Image size 2228x1652; central posterior field; retinal fundus photograph; captured after pupil dilation; 50-degree field of view — 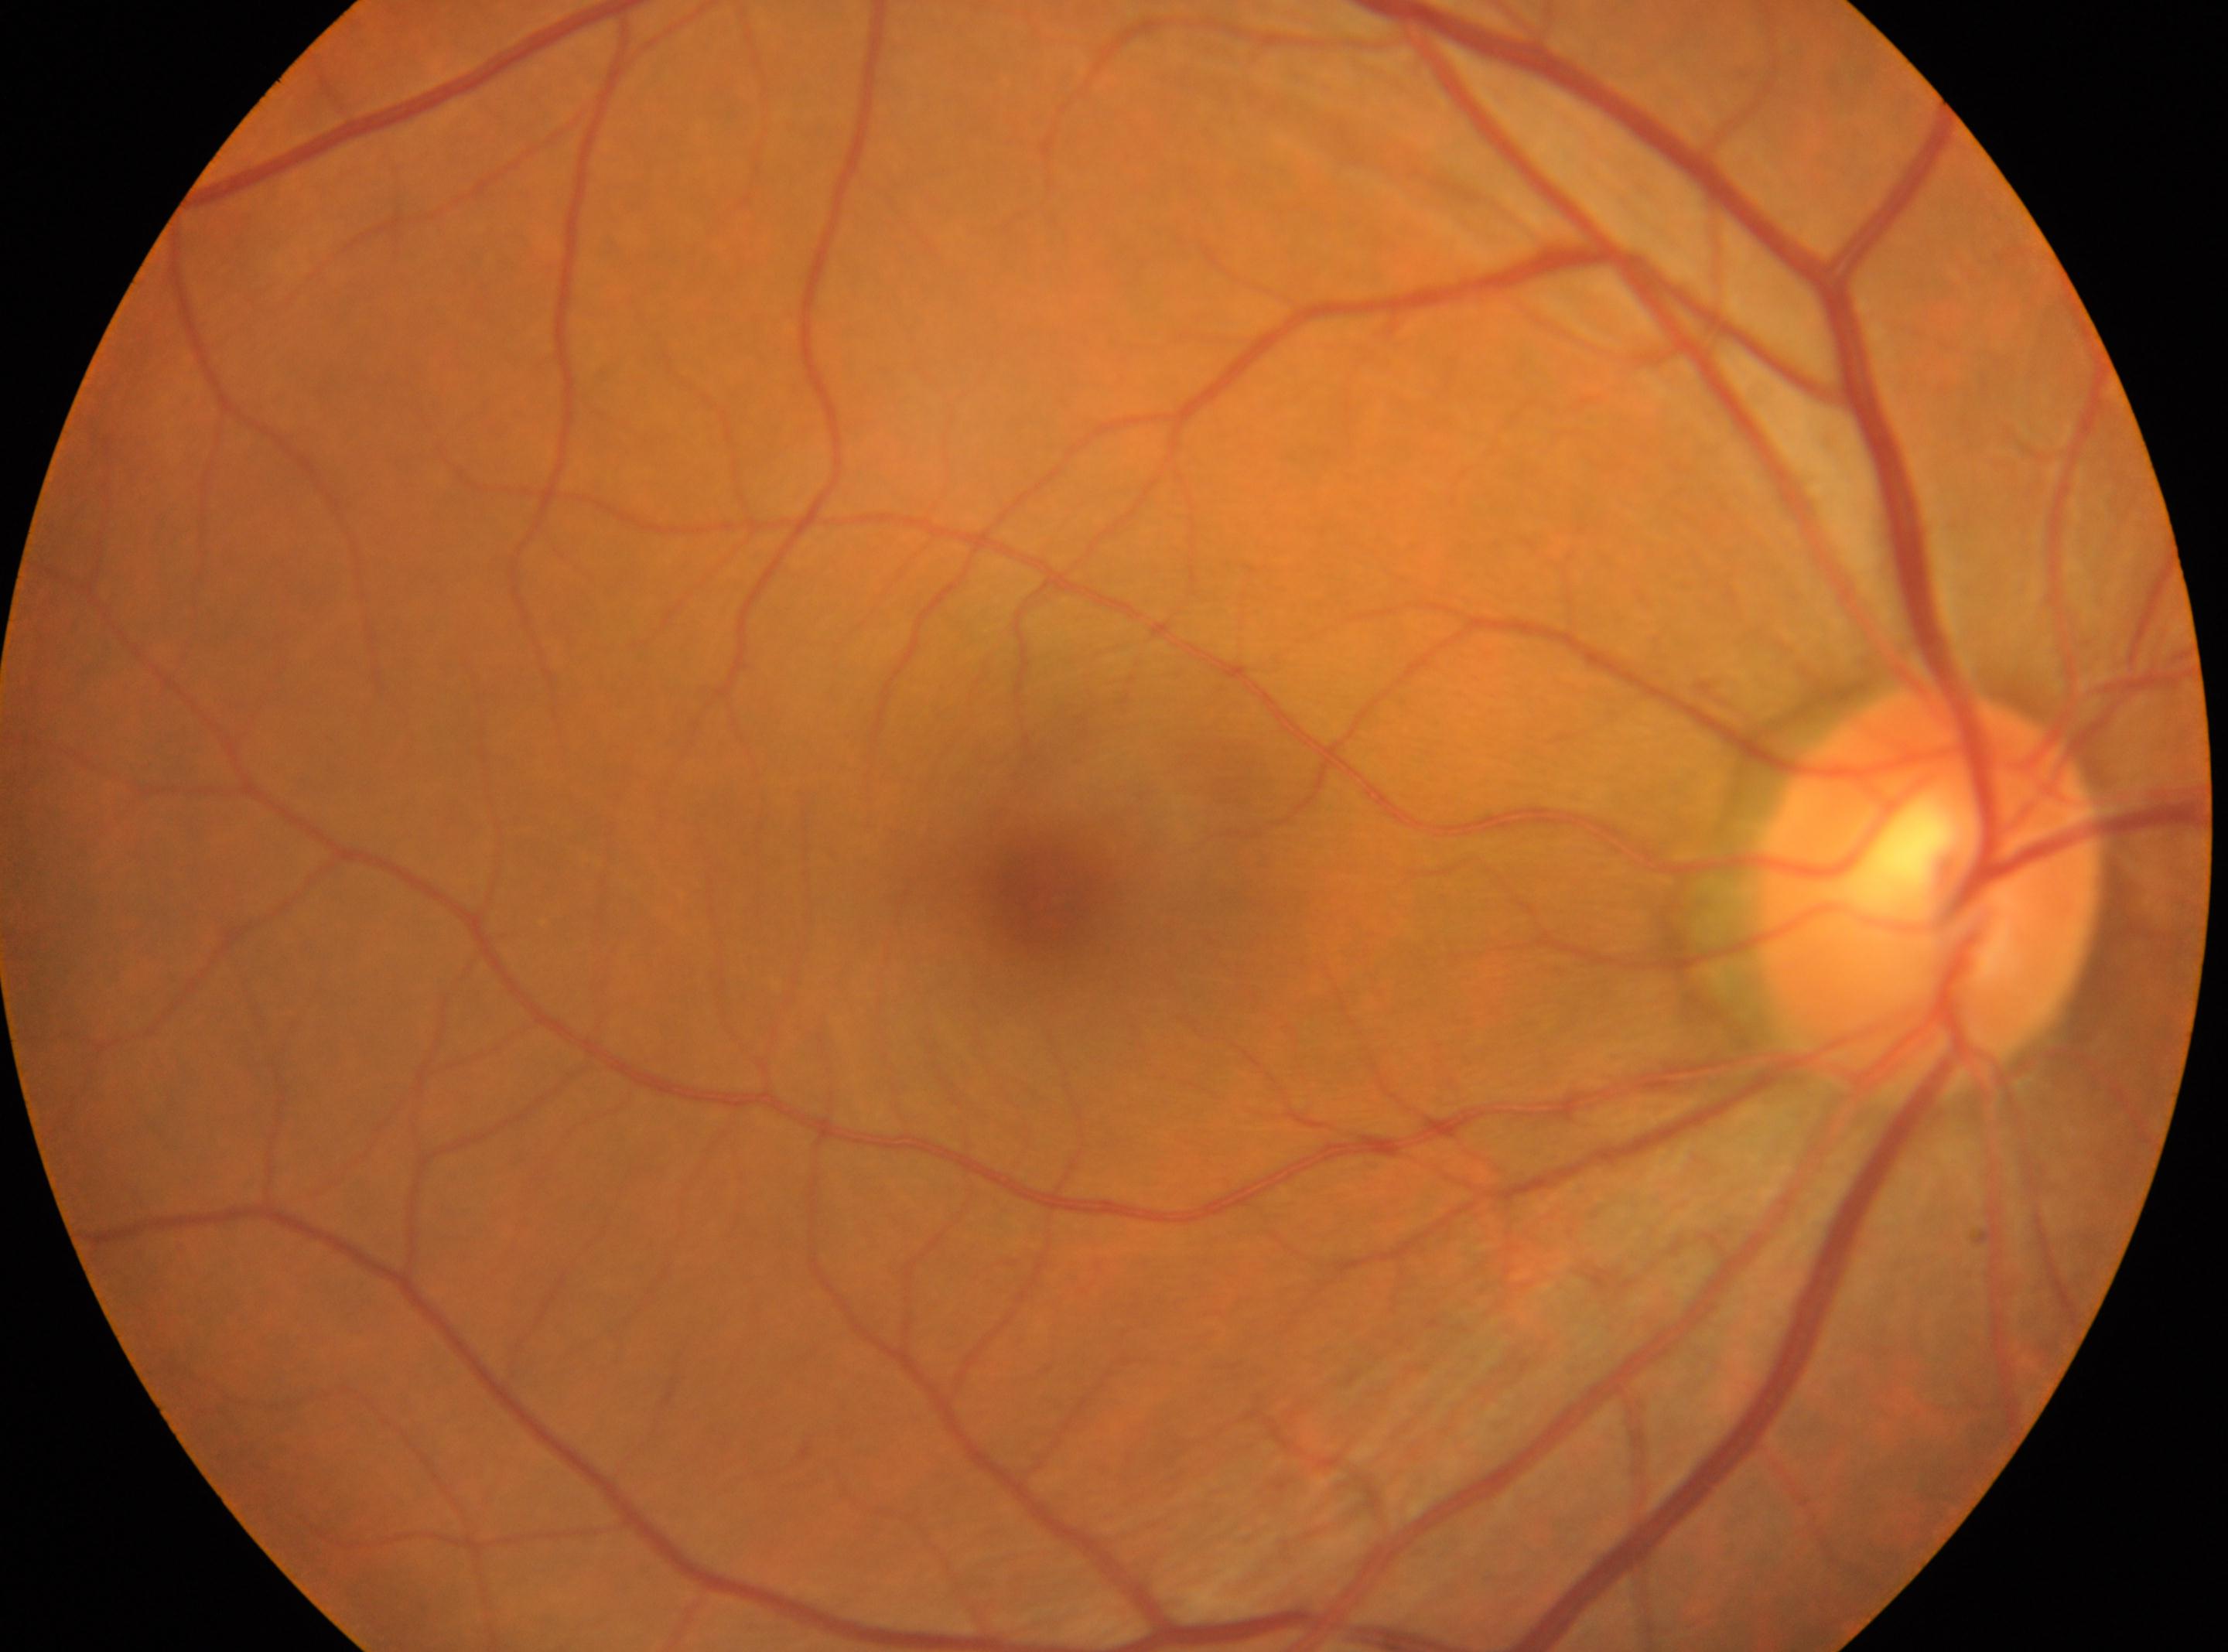 laterality = right, DR grade = 0, macular center = (1051, 905), the optic disc = (1926, 886).